Camera: Clarity RetCam 3 (130° FOV) · wide-field fundus photograph of an infant
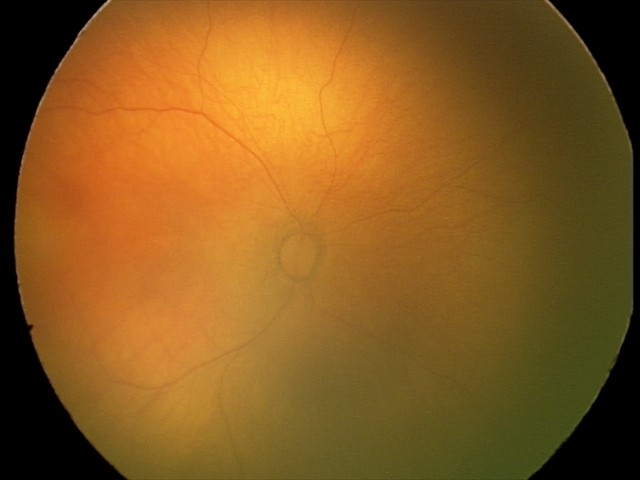 Q: What was the screening finding?
A: physiological appearance with no retinal pathology